No pharmacologic dilation — 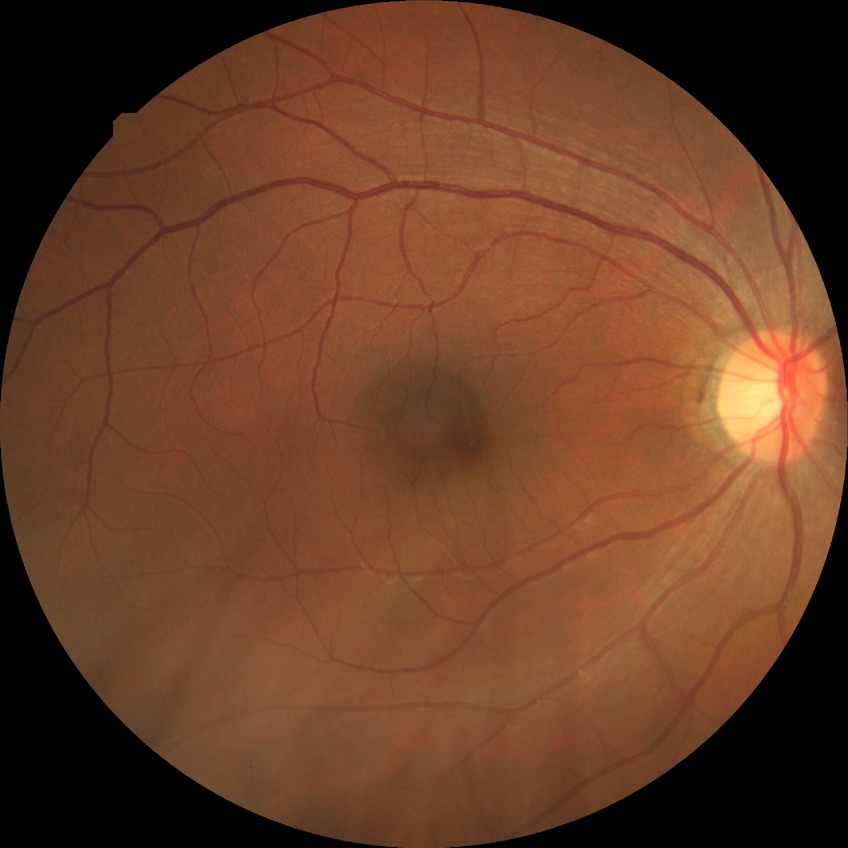 Diabetic retinopathy (DR) is no diabetic retinopathy (NDR).